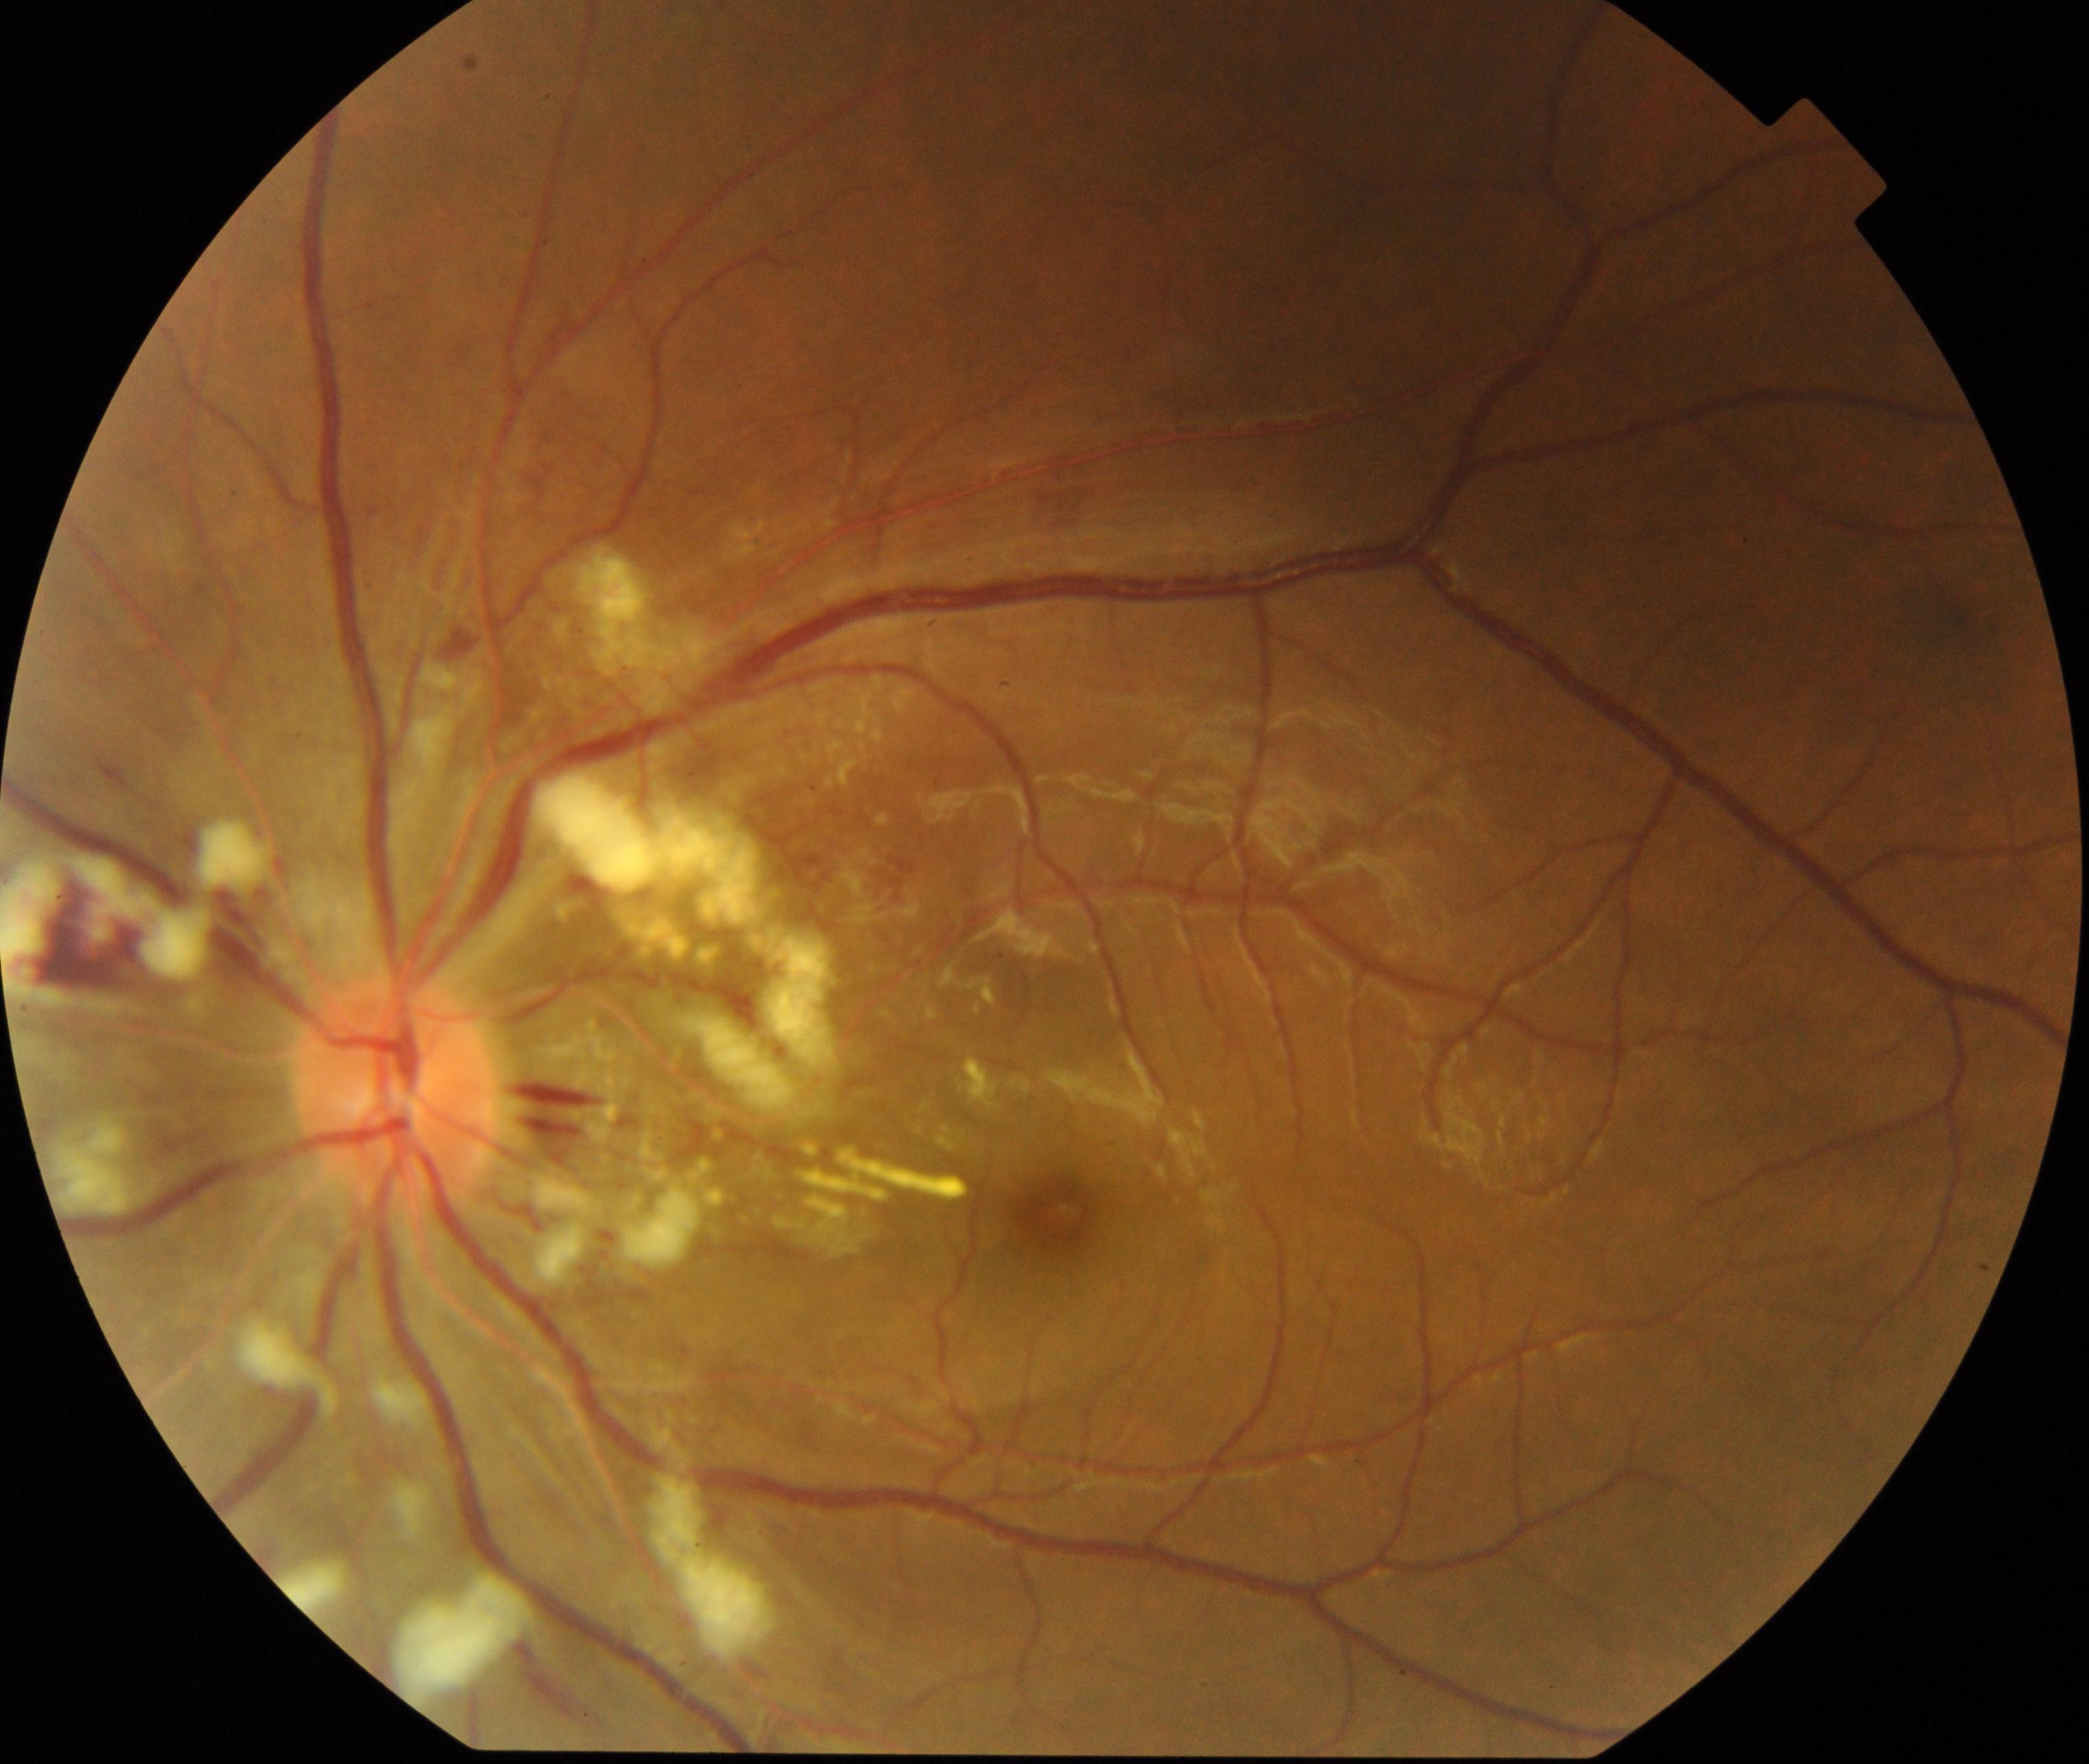 Fundus appearance consistent with severe hypertensive retinopathy. Features include cotton-wool spots, arteriolar narrowing, arteriolosclerosis, flame-shaped hemorrhages, retinal edema, macular star, and disc edema.